2048x1536:
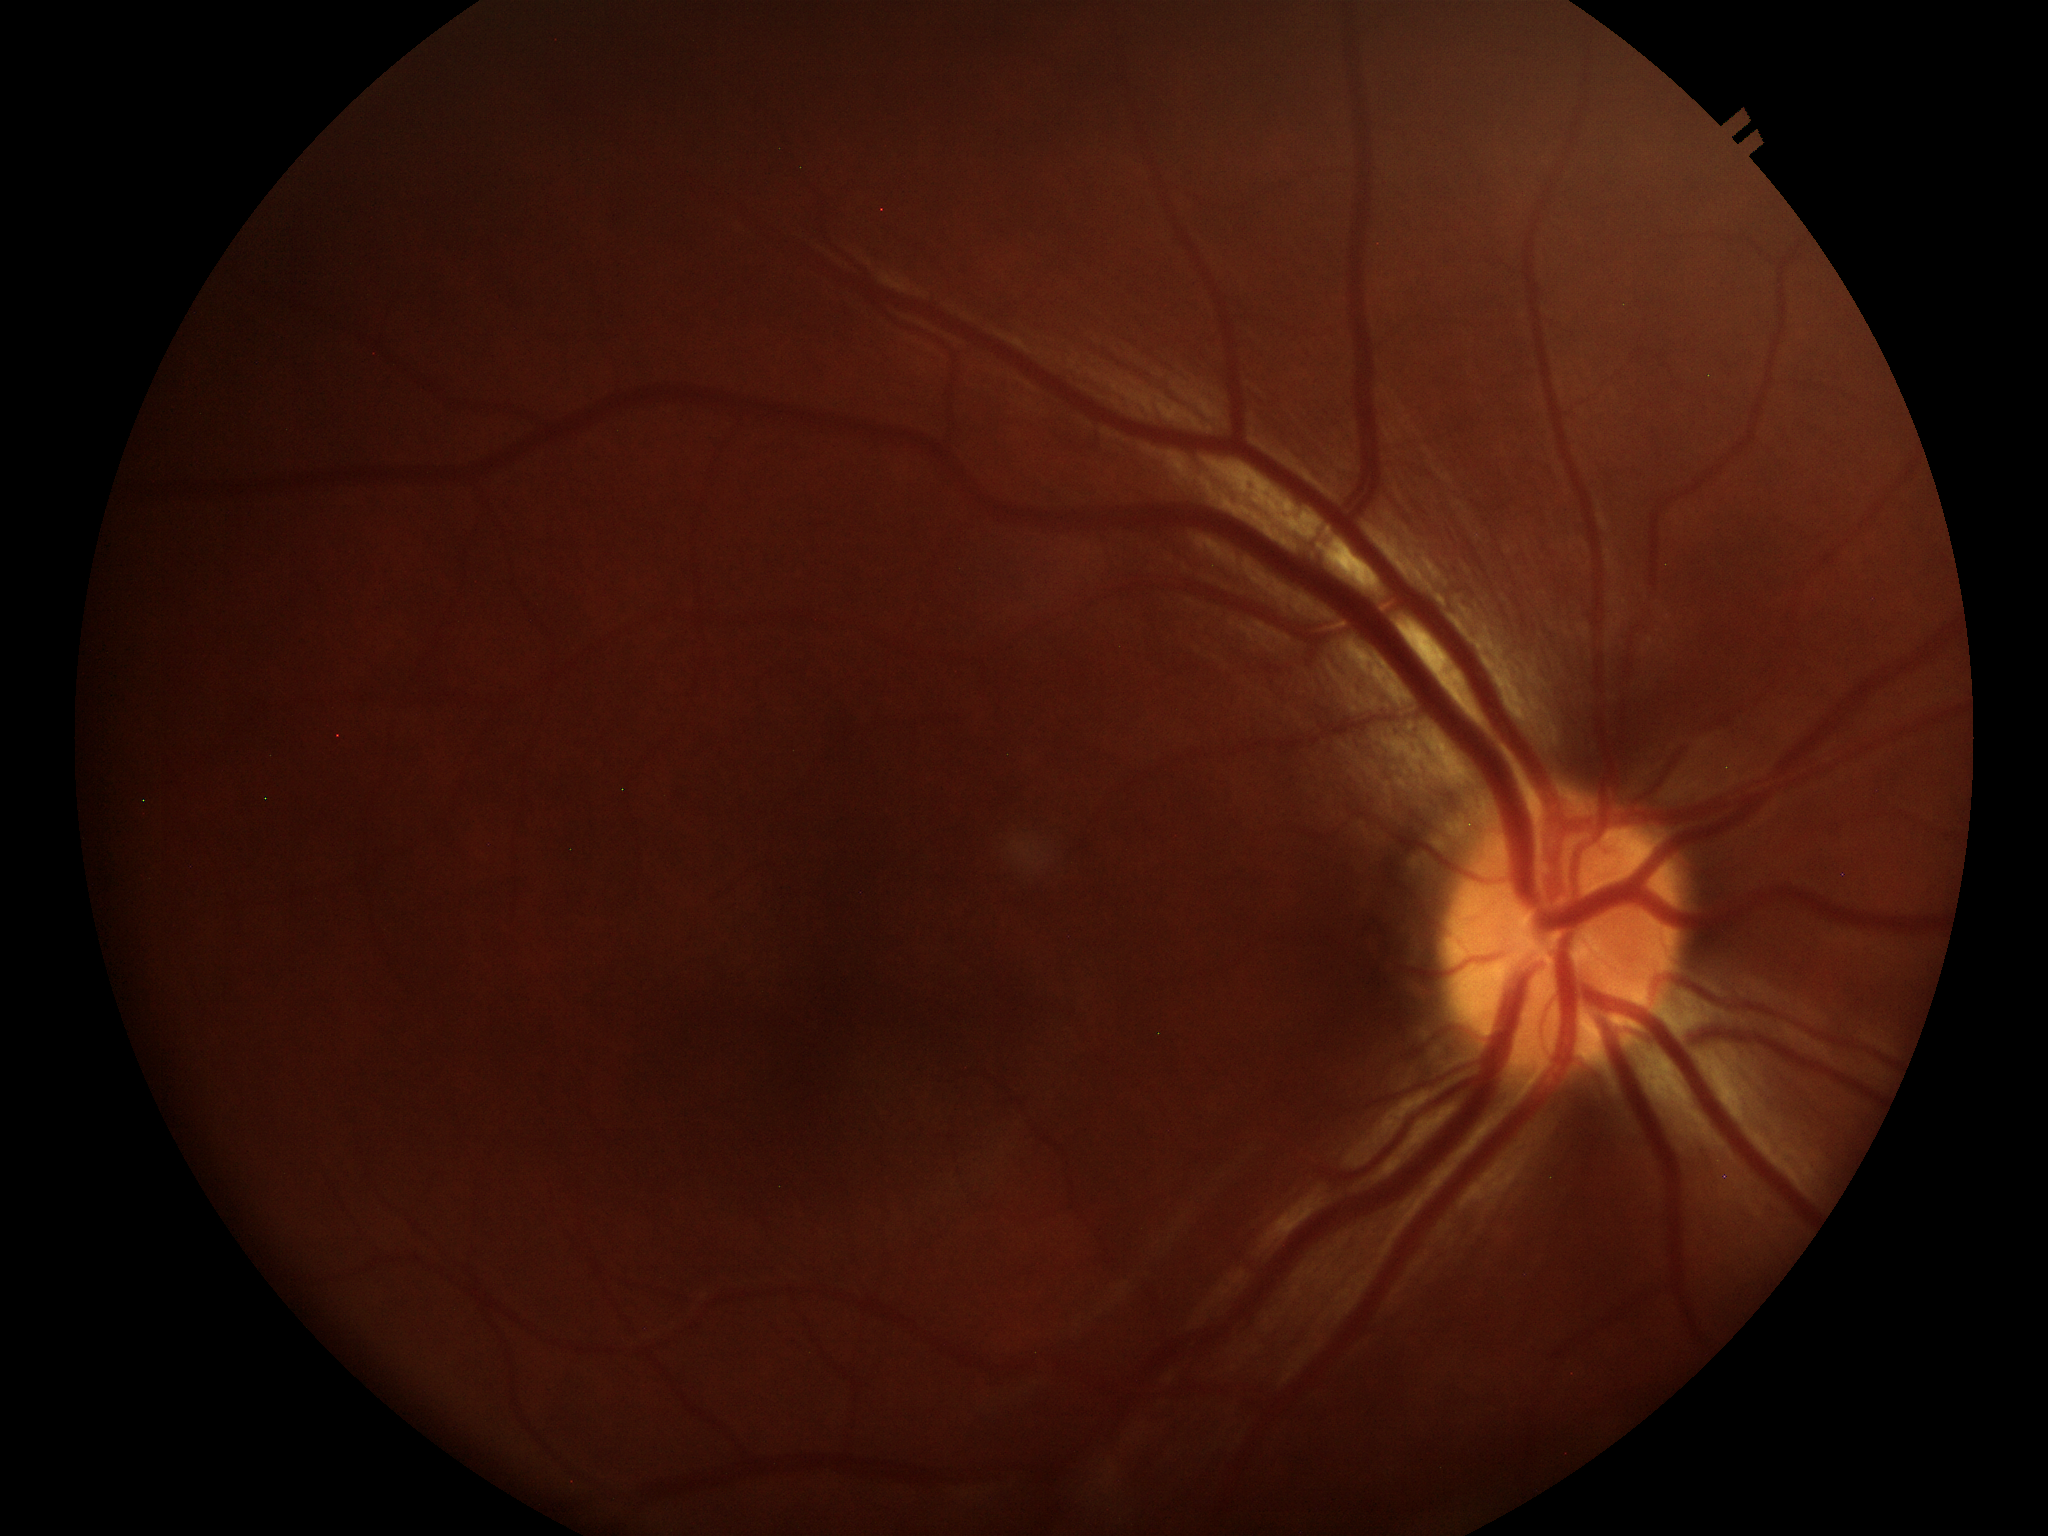 vertical CDR (VCDR): 0.39
Glaucoma evaluation: negative